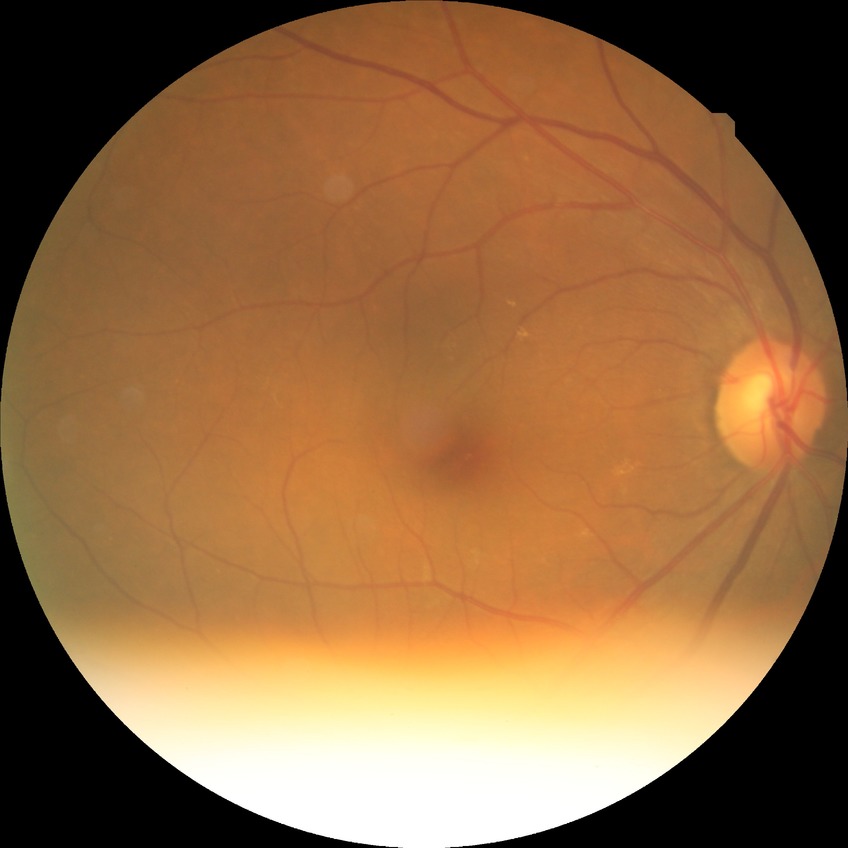

– diabetic retinopathy (DR) — NDR (no diabetic retinopathy)